2212x1659px, color fundus image, 45° FOV:
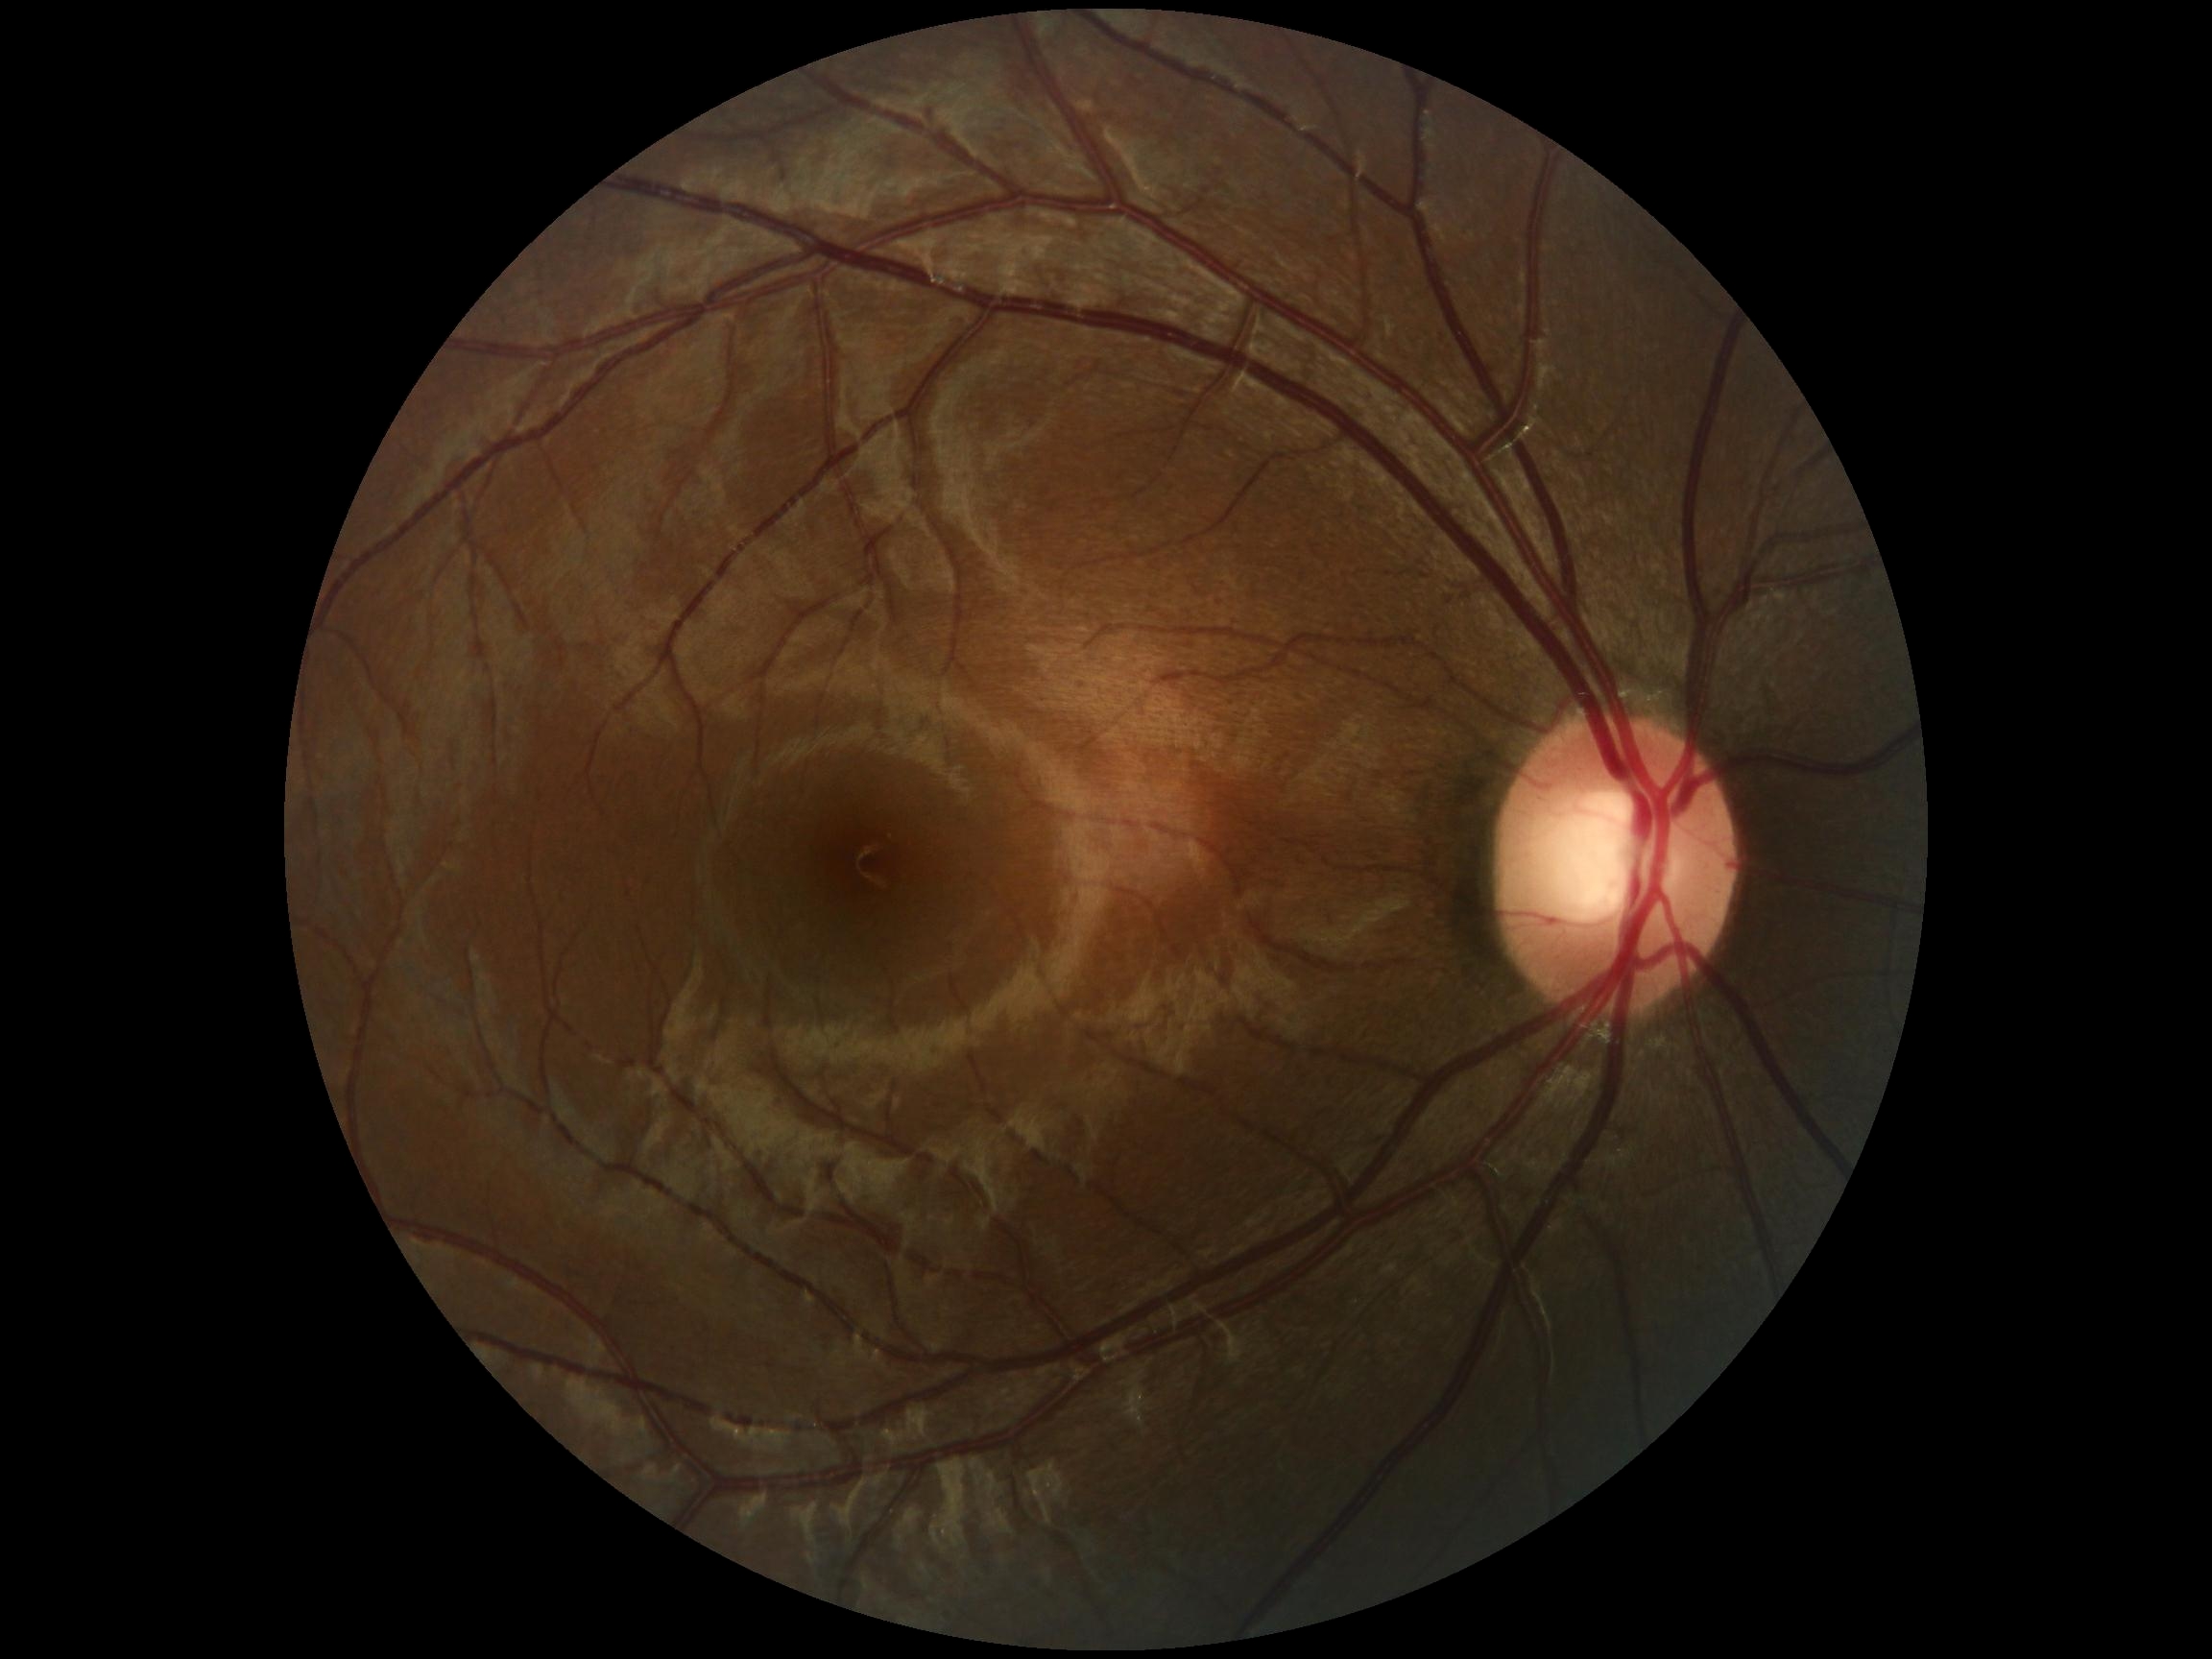 No DR findings. Diabetic retinopathy (DR) is grade 0.